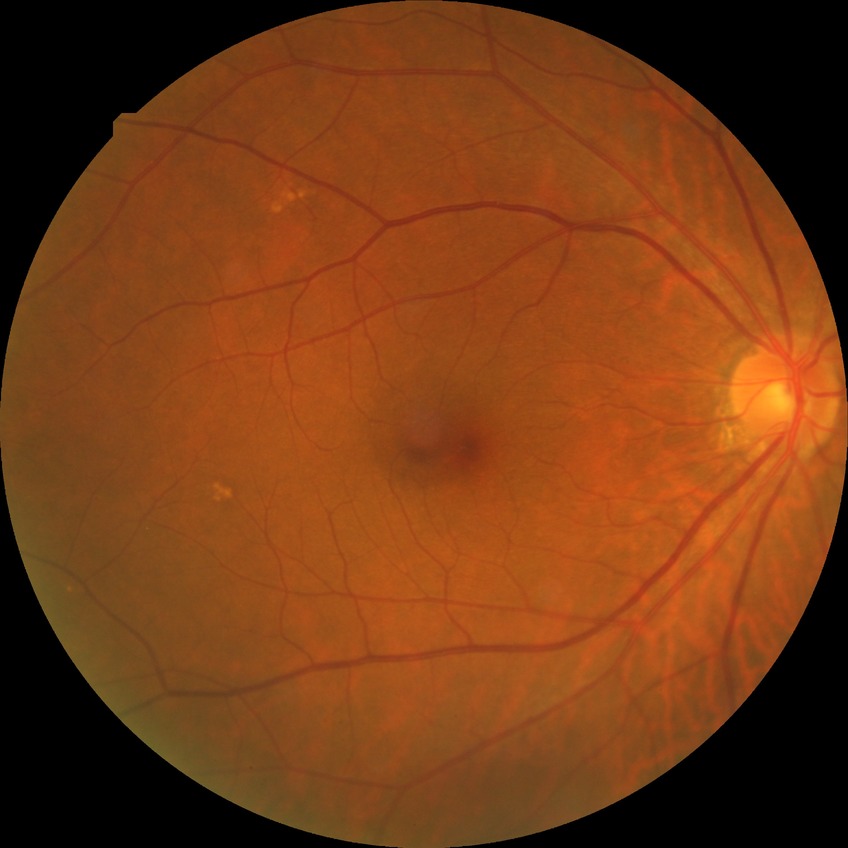

Diabetic retinopathy (DR): simple diabetic retinopathy (SDR).